Macula-centered
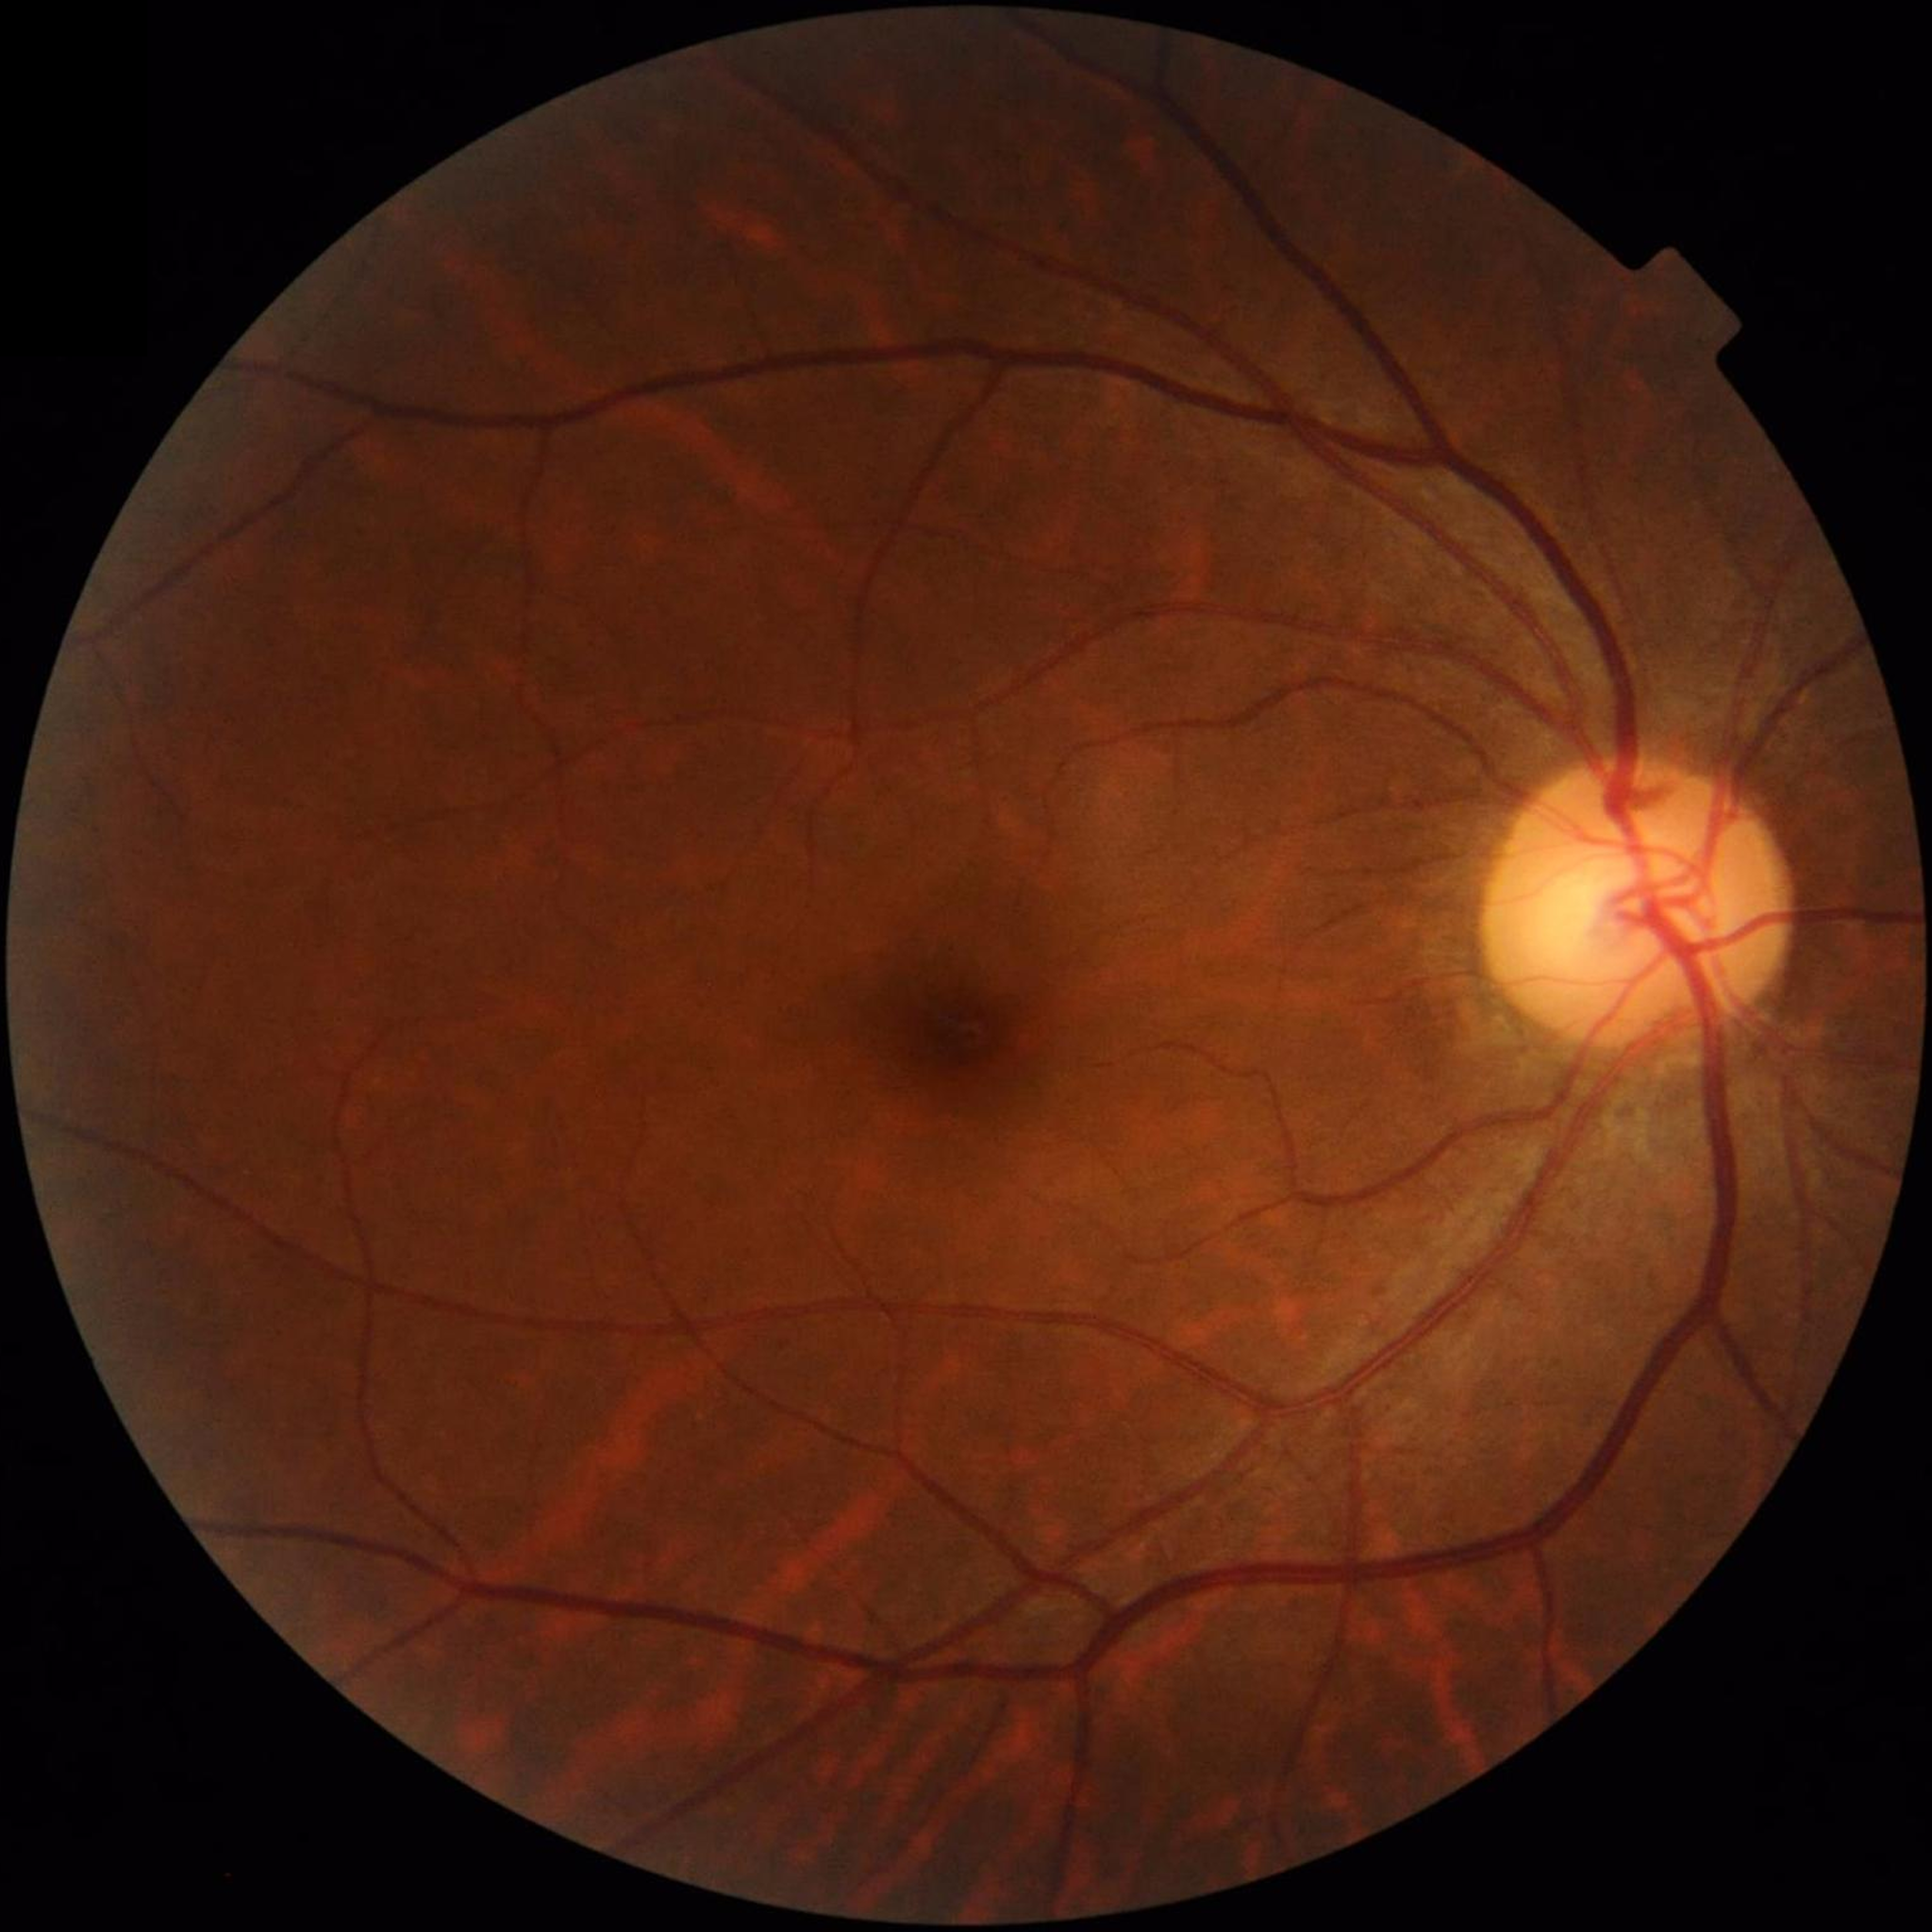

Quality assessment: good.
Color fundus photograph with no signs of AMD, diabetic retinopathy, or glaucoma.